45° FOV: 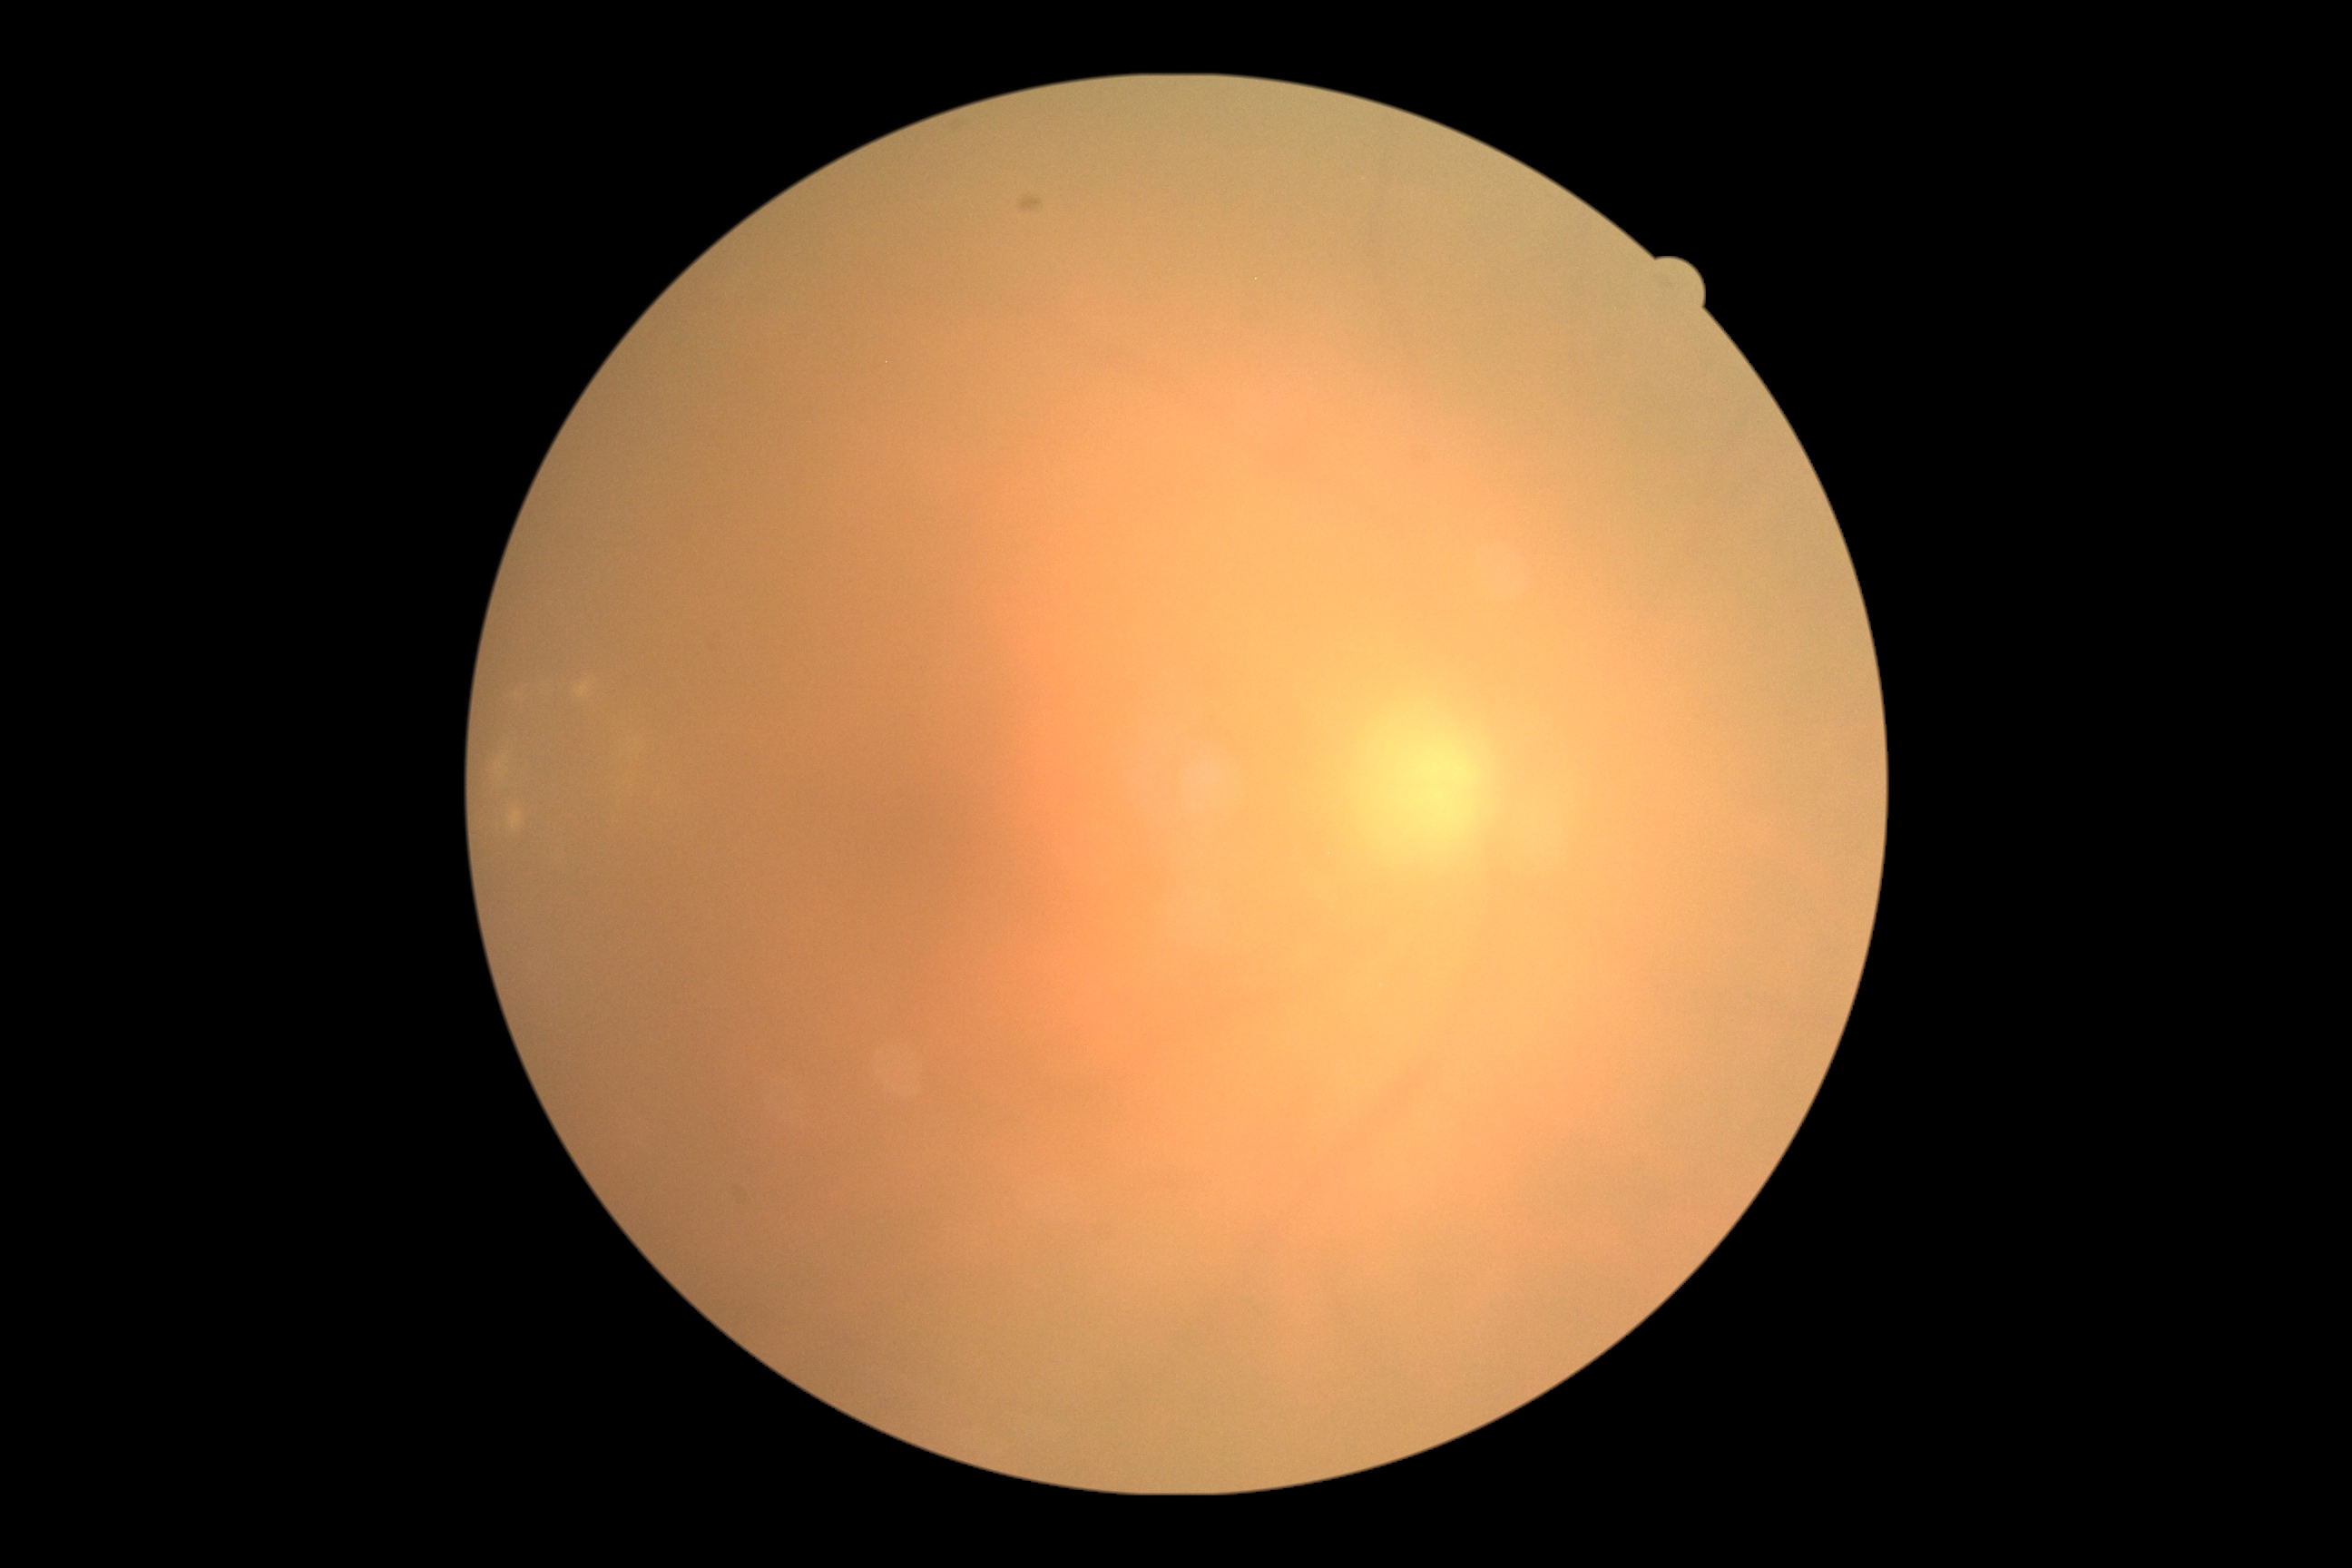 Quality too poor to assess for DR. Diabetic retinopathy (DR): ungradable.